Non-mydriatic fundus camera
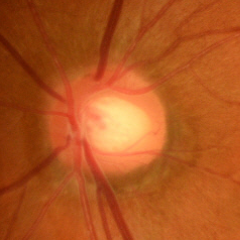 Glaucoma is present. Glaucoma stage: early glaucomatous changes.